Color fundus image; 2352 x 1568 pixels; 45° field of view — 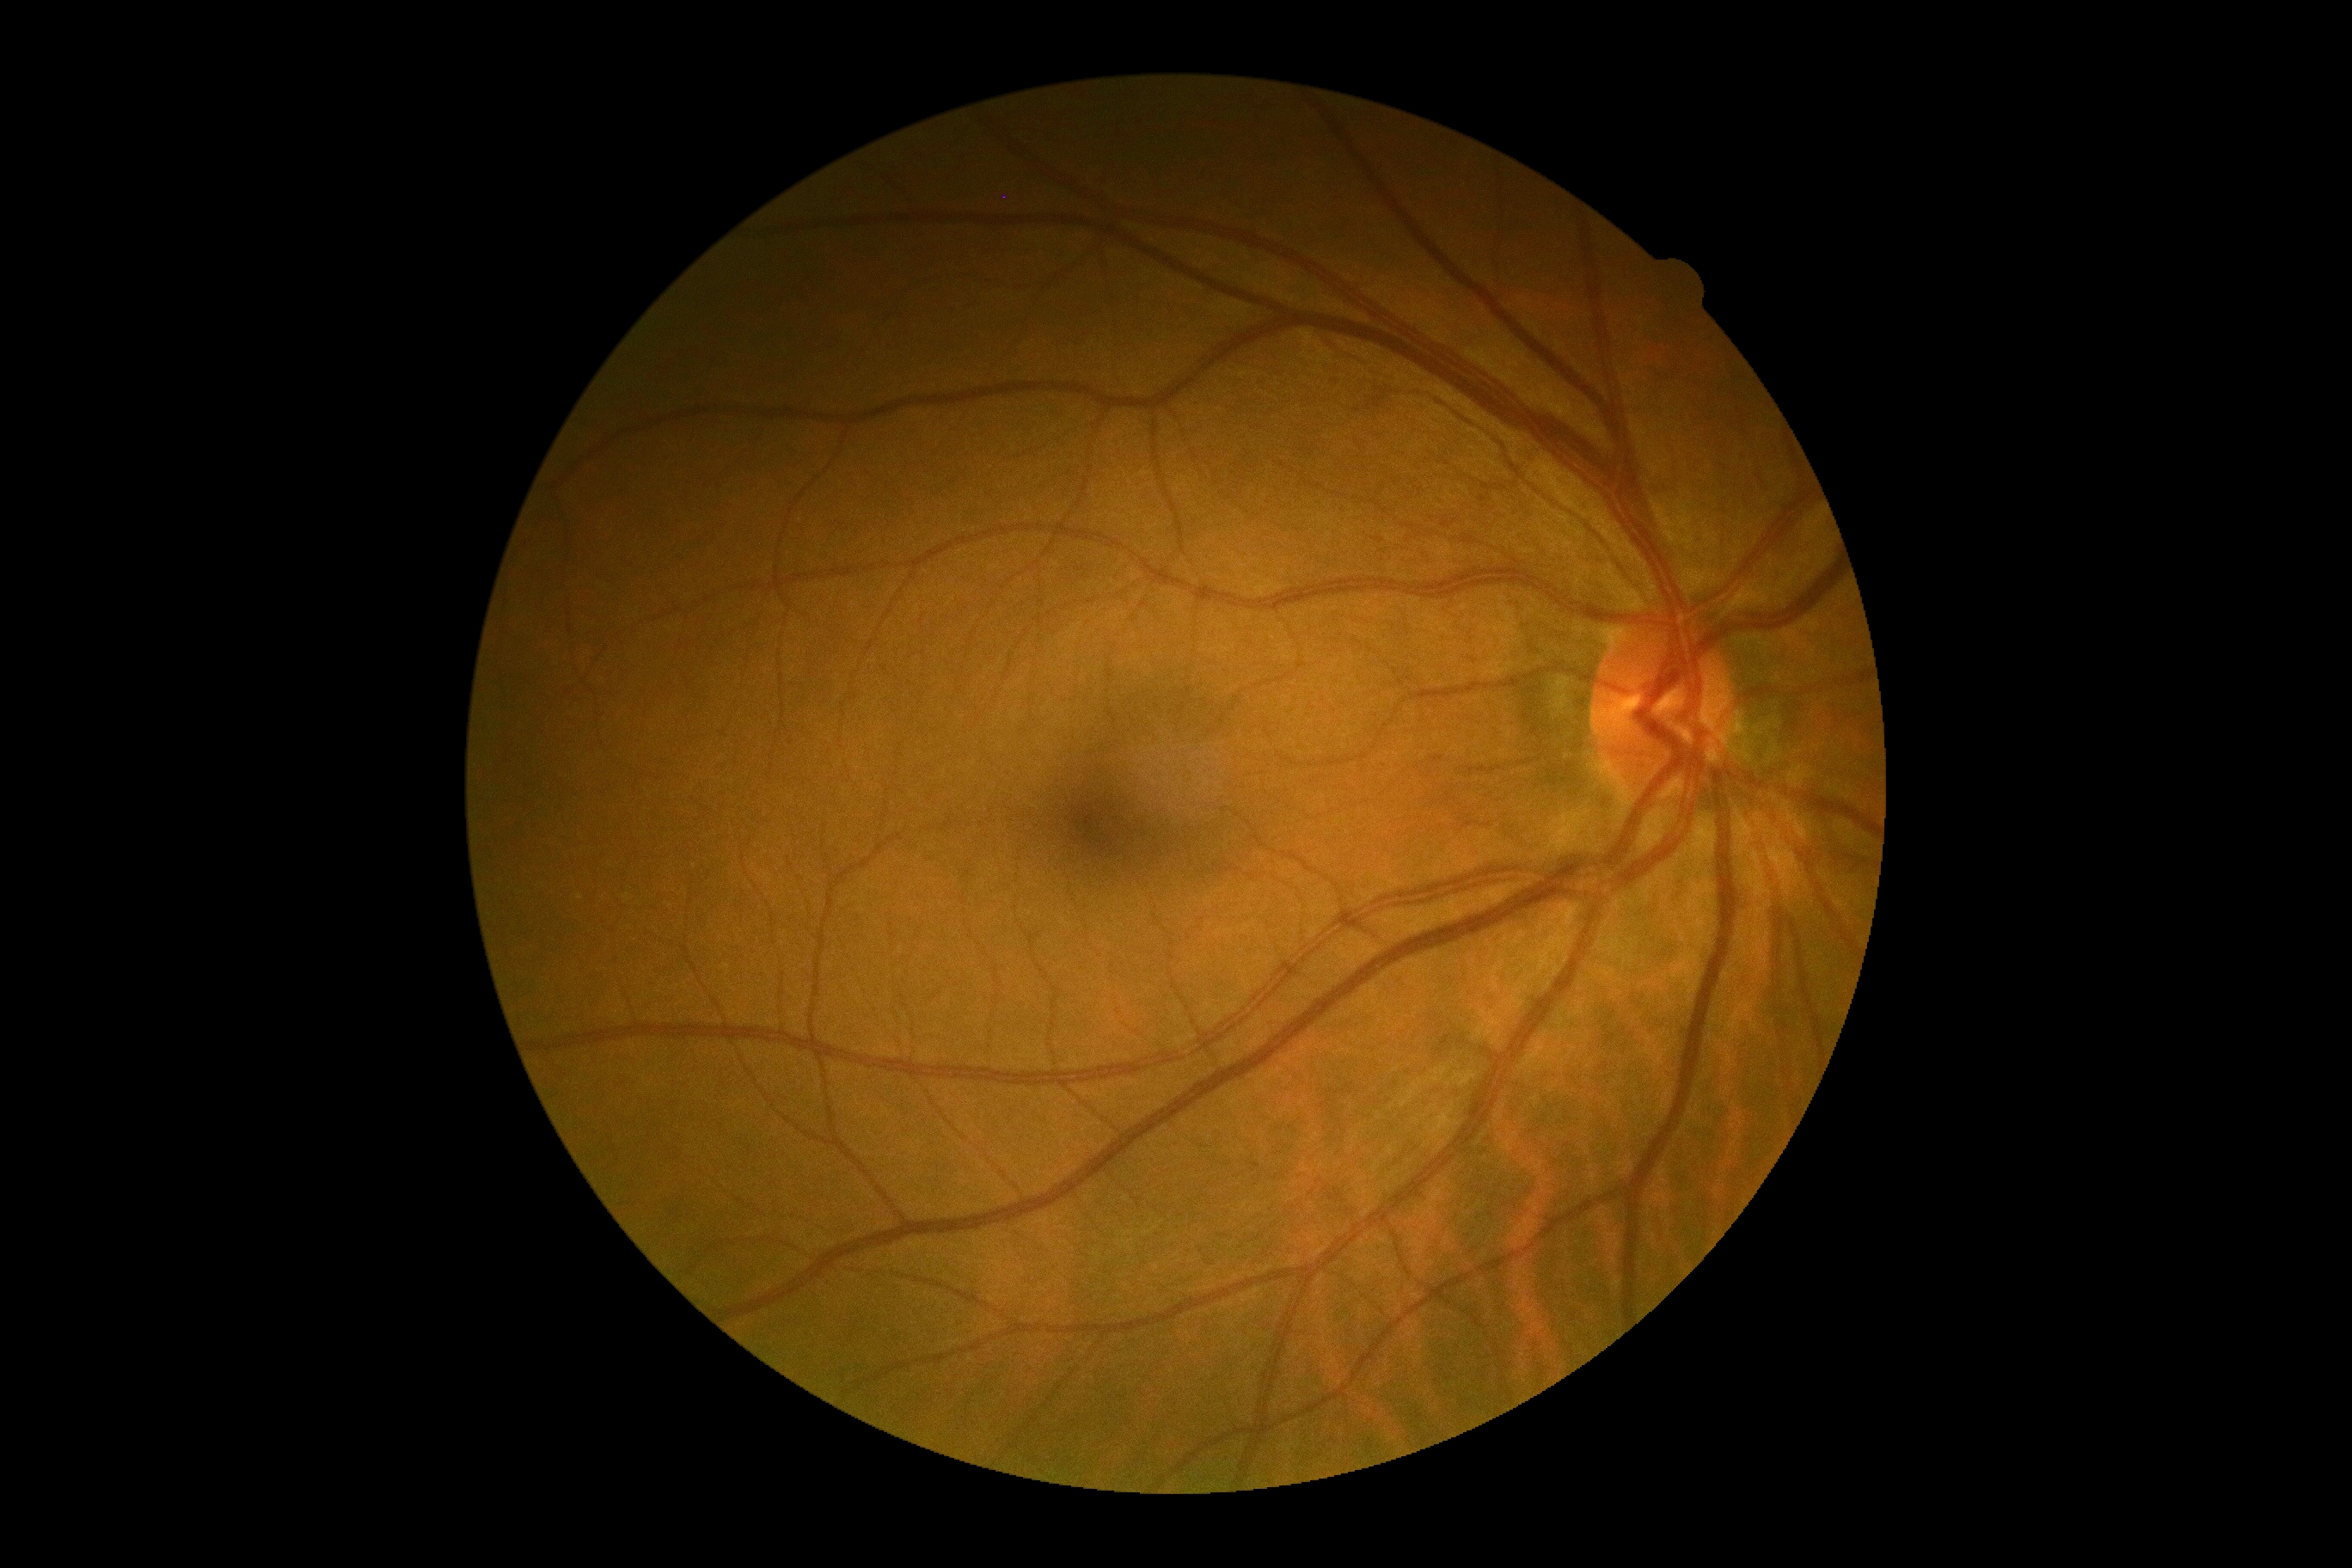

DR = grade 0 — no visible signs of diabetic retinopathy